Color fundus image · 45° field of view · 848 x 848 pixels · camera: NIDEK AFC-230: 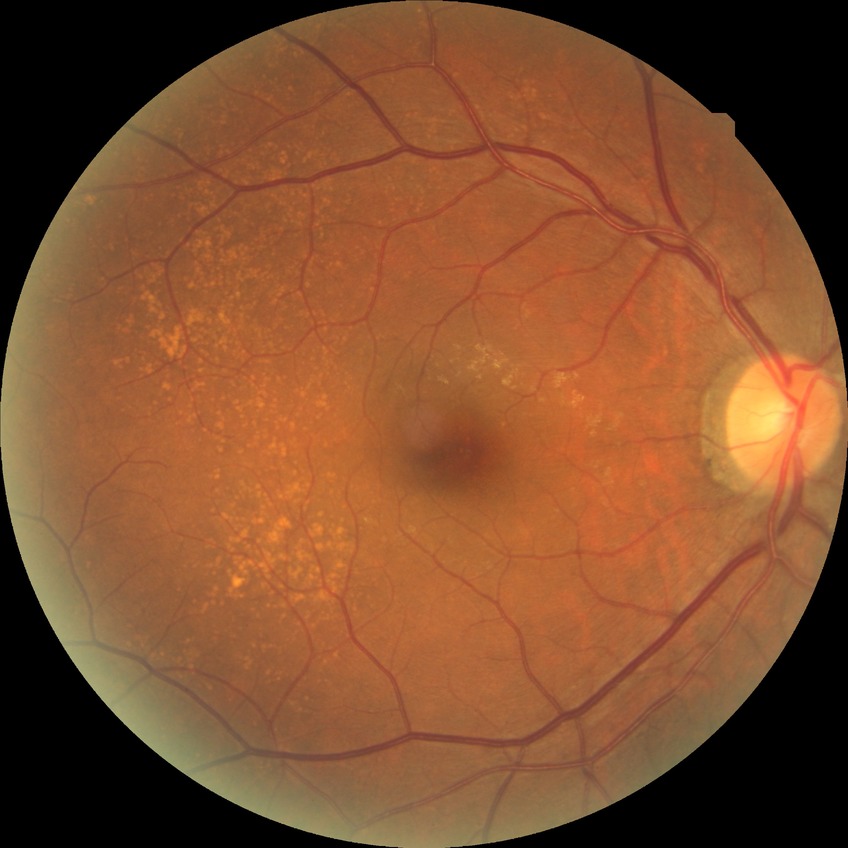 diabetic retinopathy grade = no diabetic retinopathy